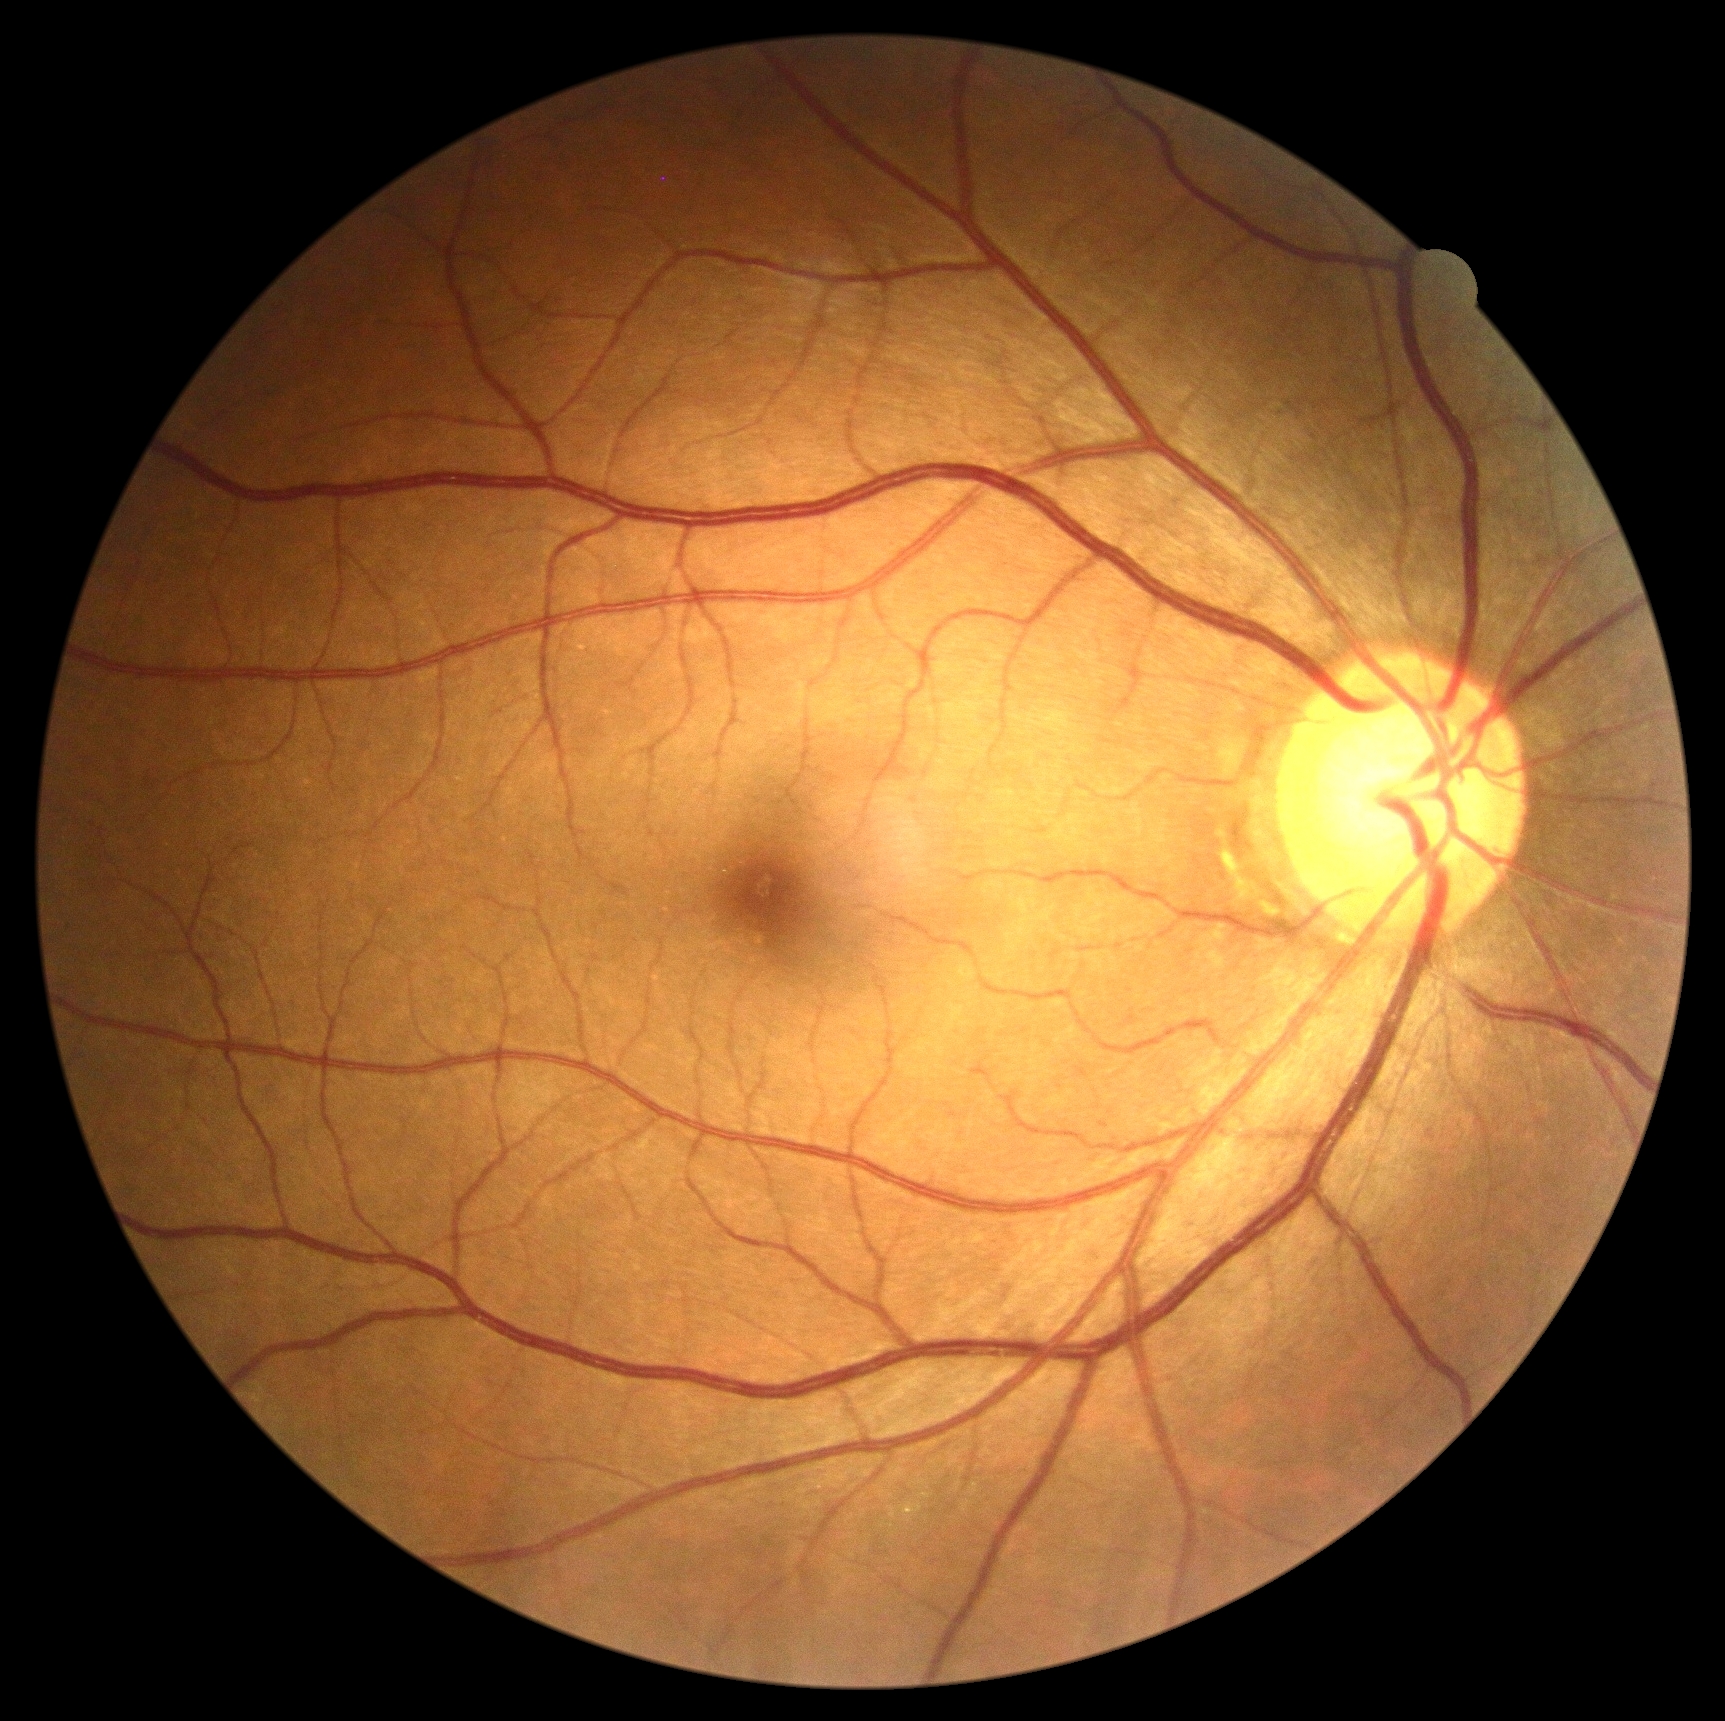
Retinopathy: grade 0 (no apparent retinopathy).